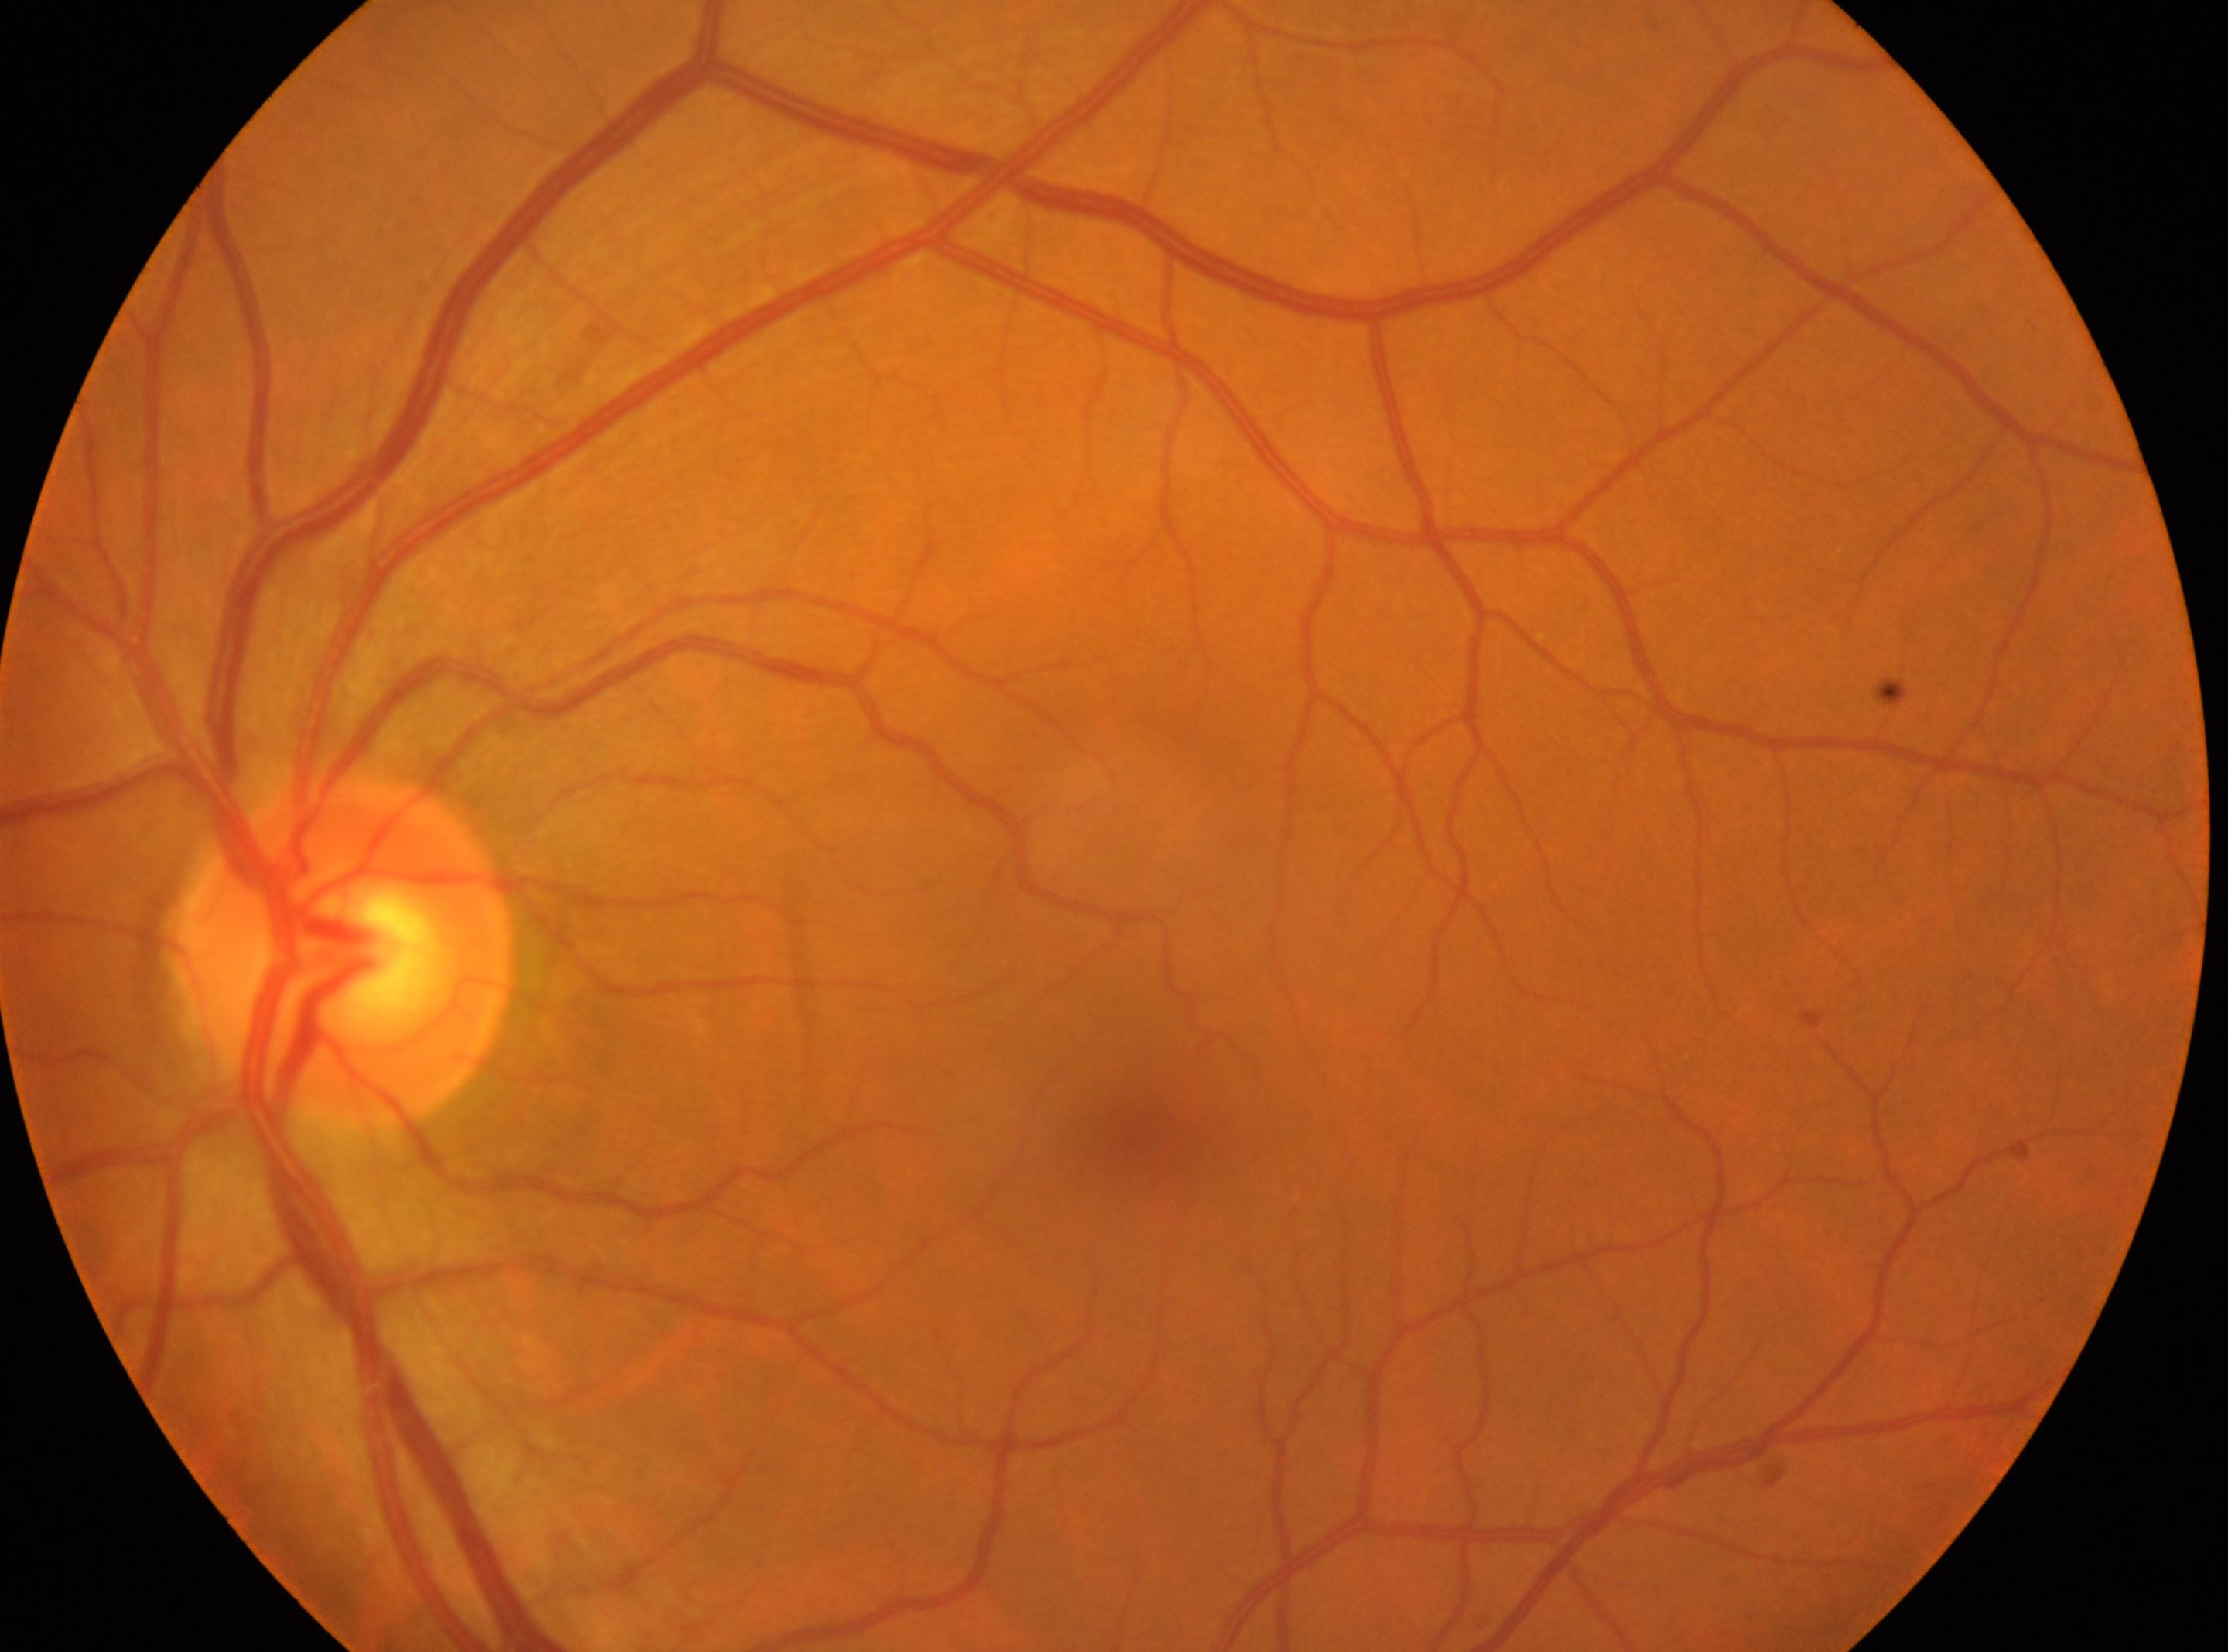
No DR findings.
Diabetic retinopathy (DR) is 0/4.
The fovea is at 1145, 1129.
ONH located at 344, 950.
Imaged eye: oculus sinister.